45° FOV: 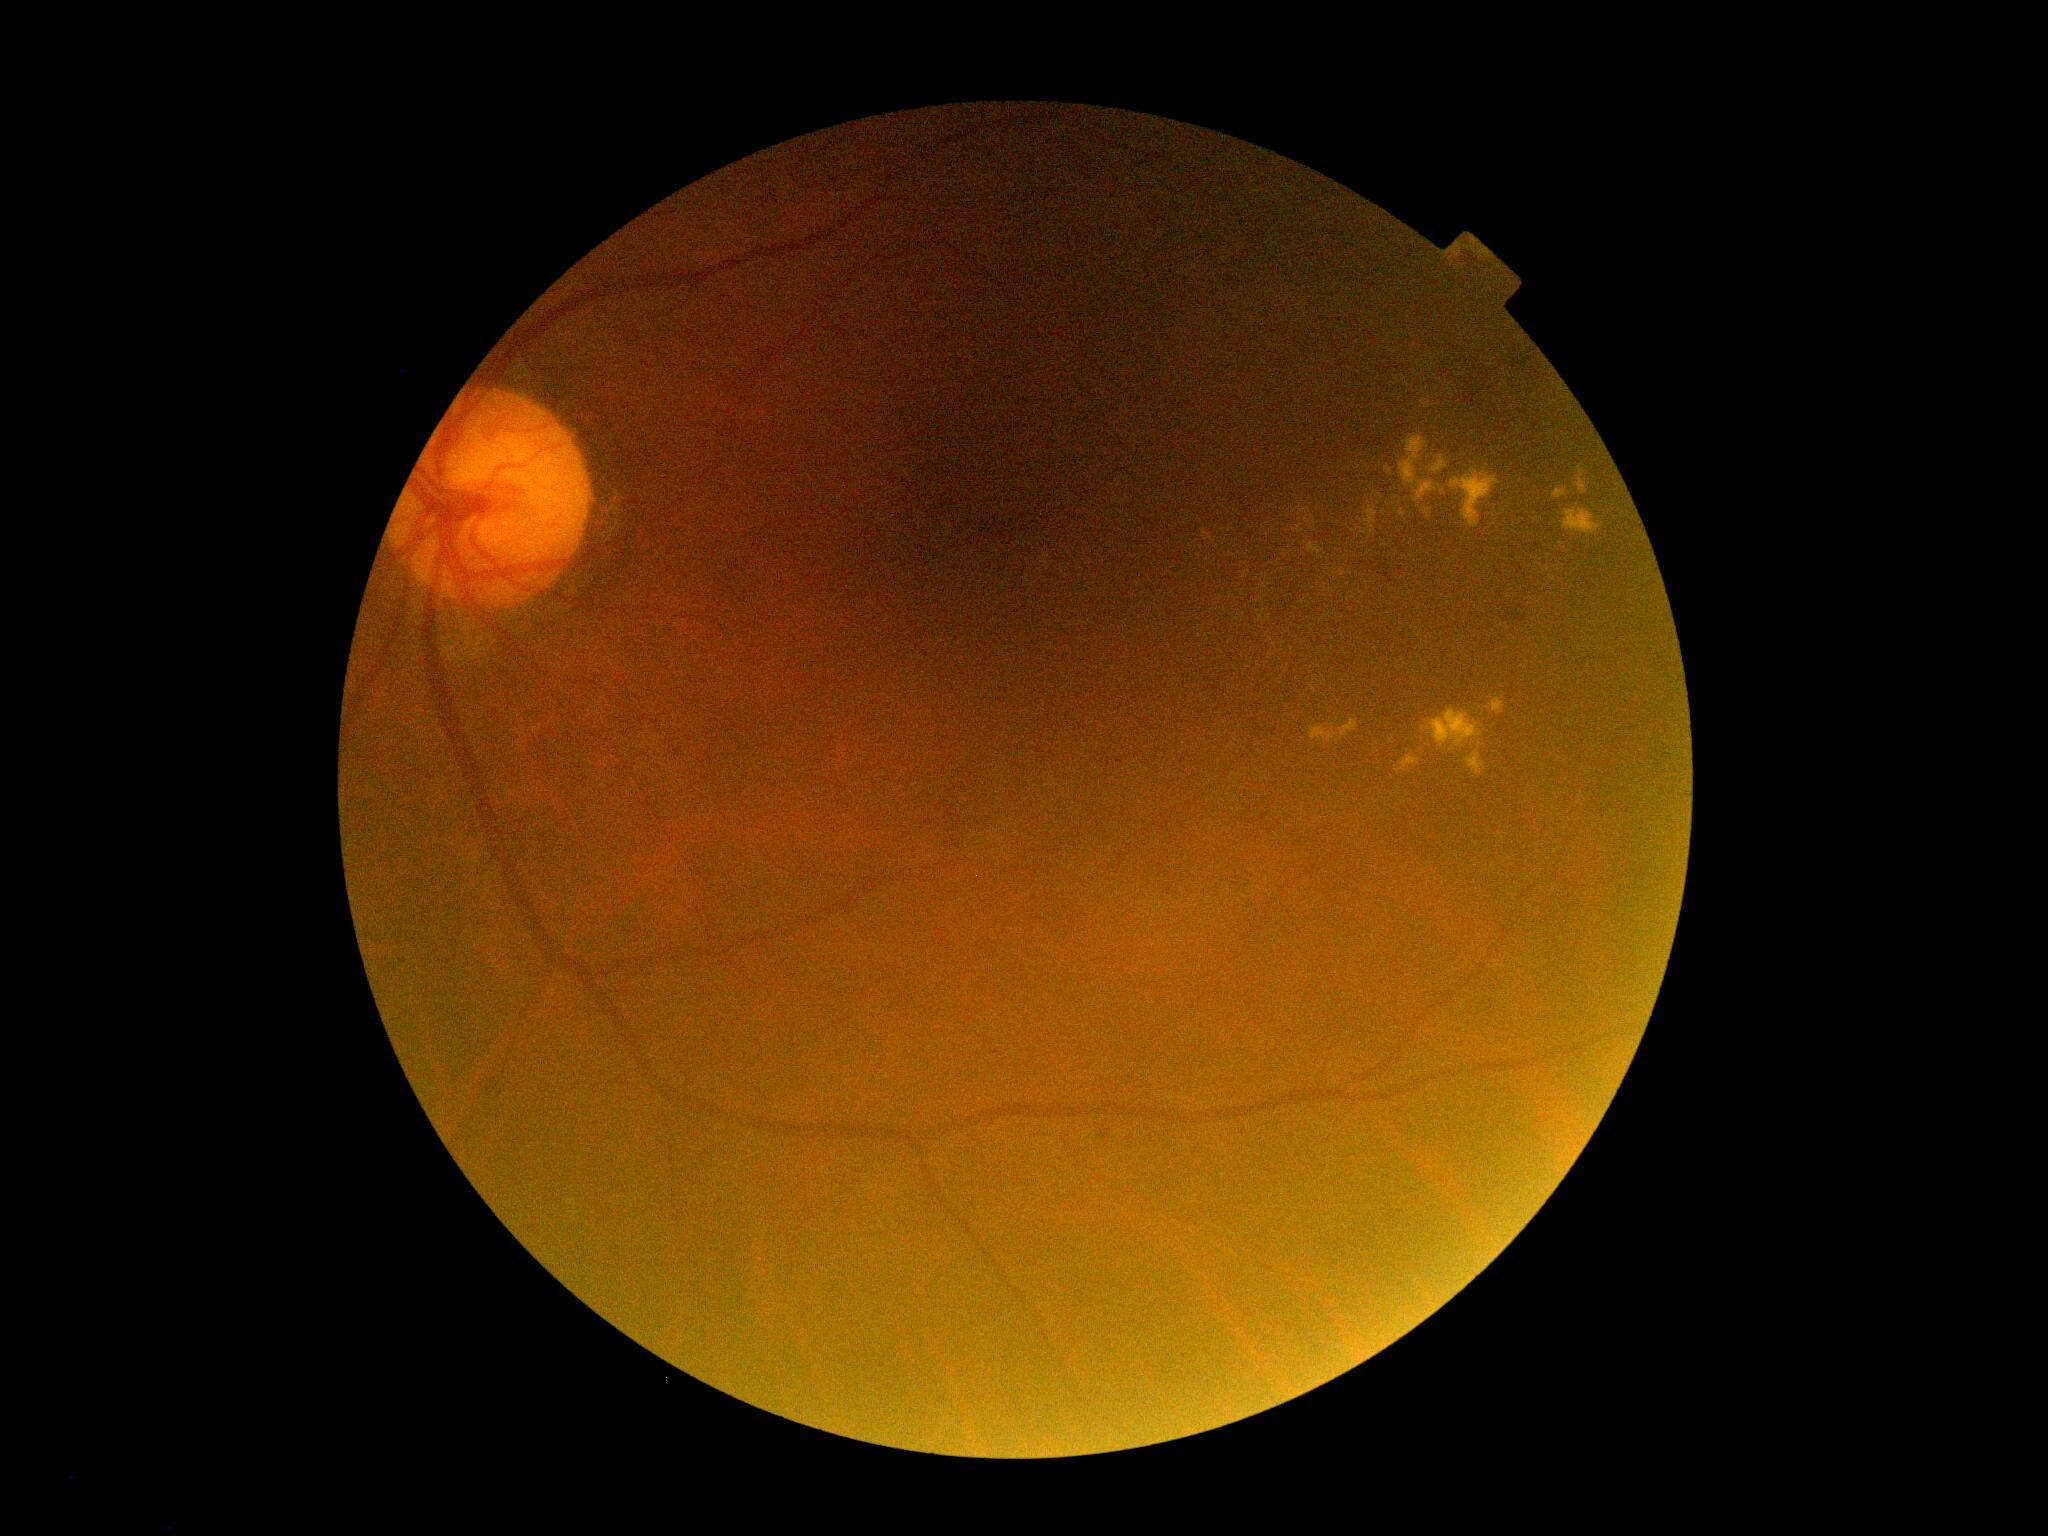 Retinopathy: 2.